Modified Davis classification · nonmydriatic fundus photograph · retinal fundus photograph — 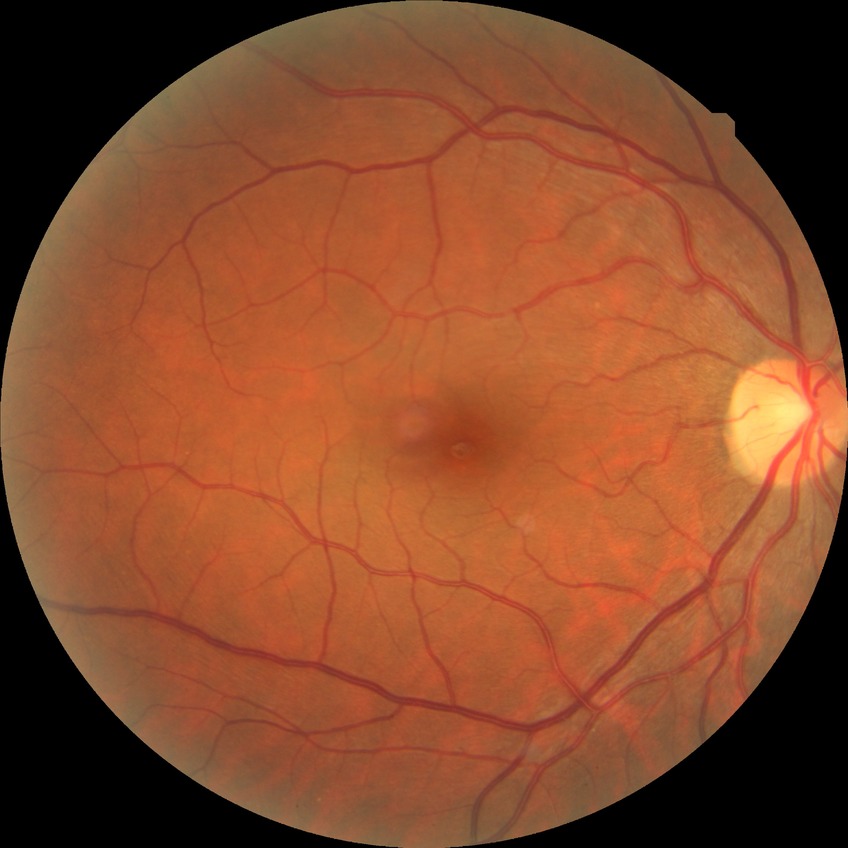
retinopathy grade: no diabetic retinopathy.